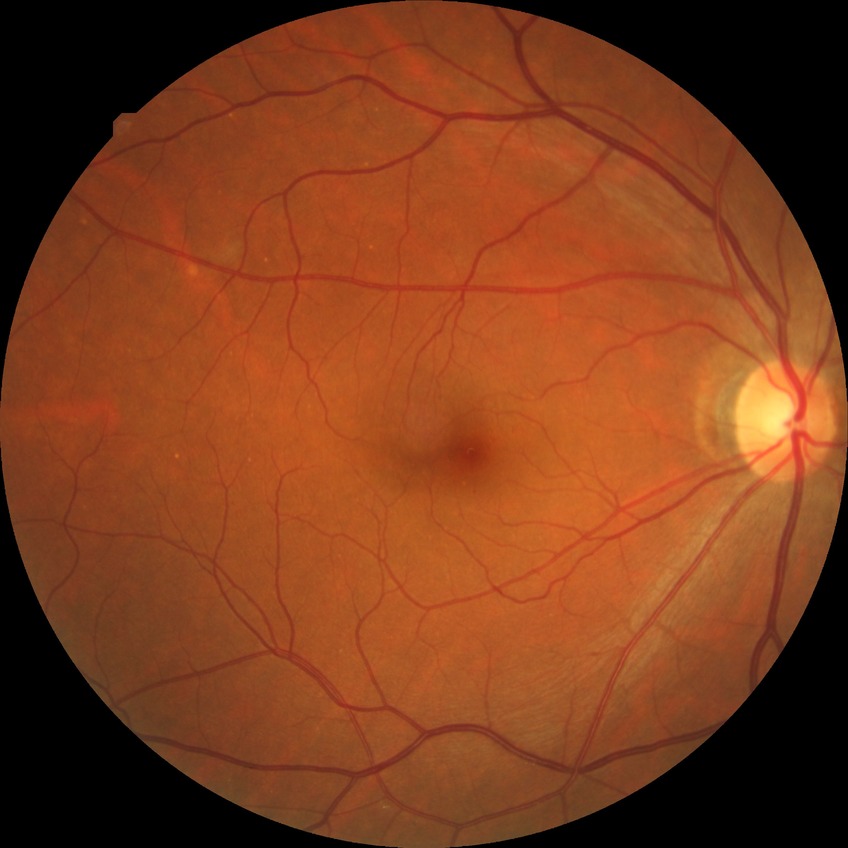
Diabetic retinopathy severity is no diabetic retinopathy.